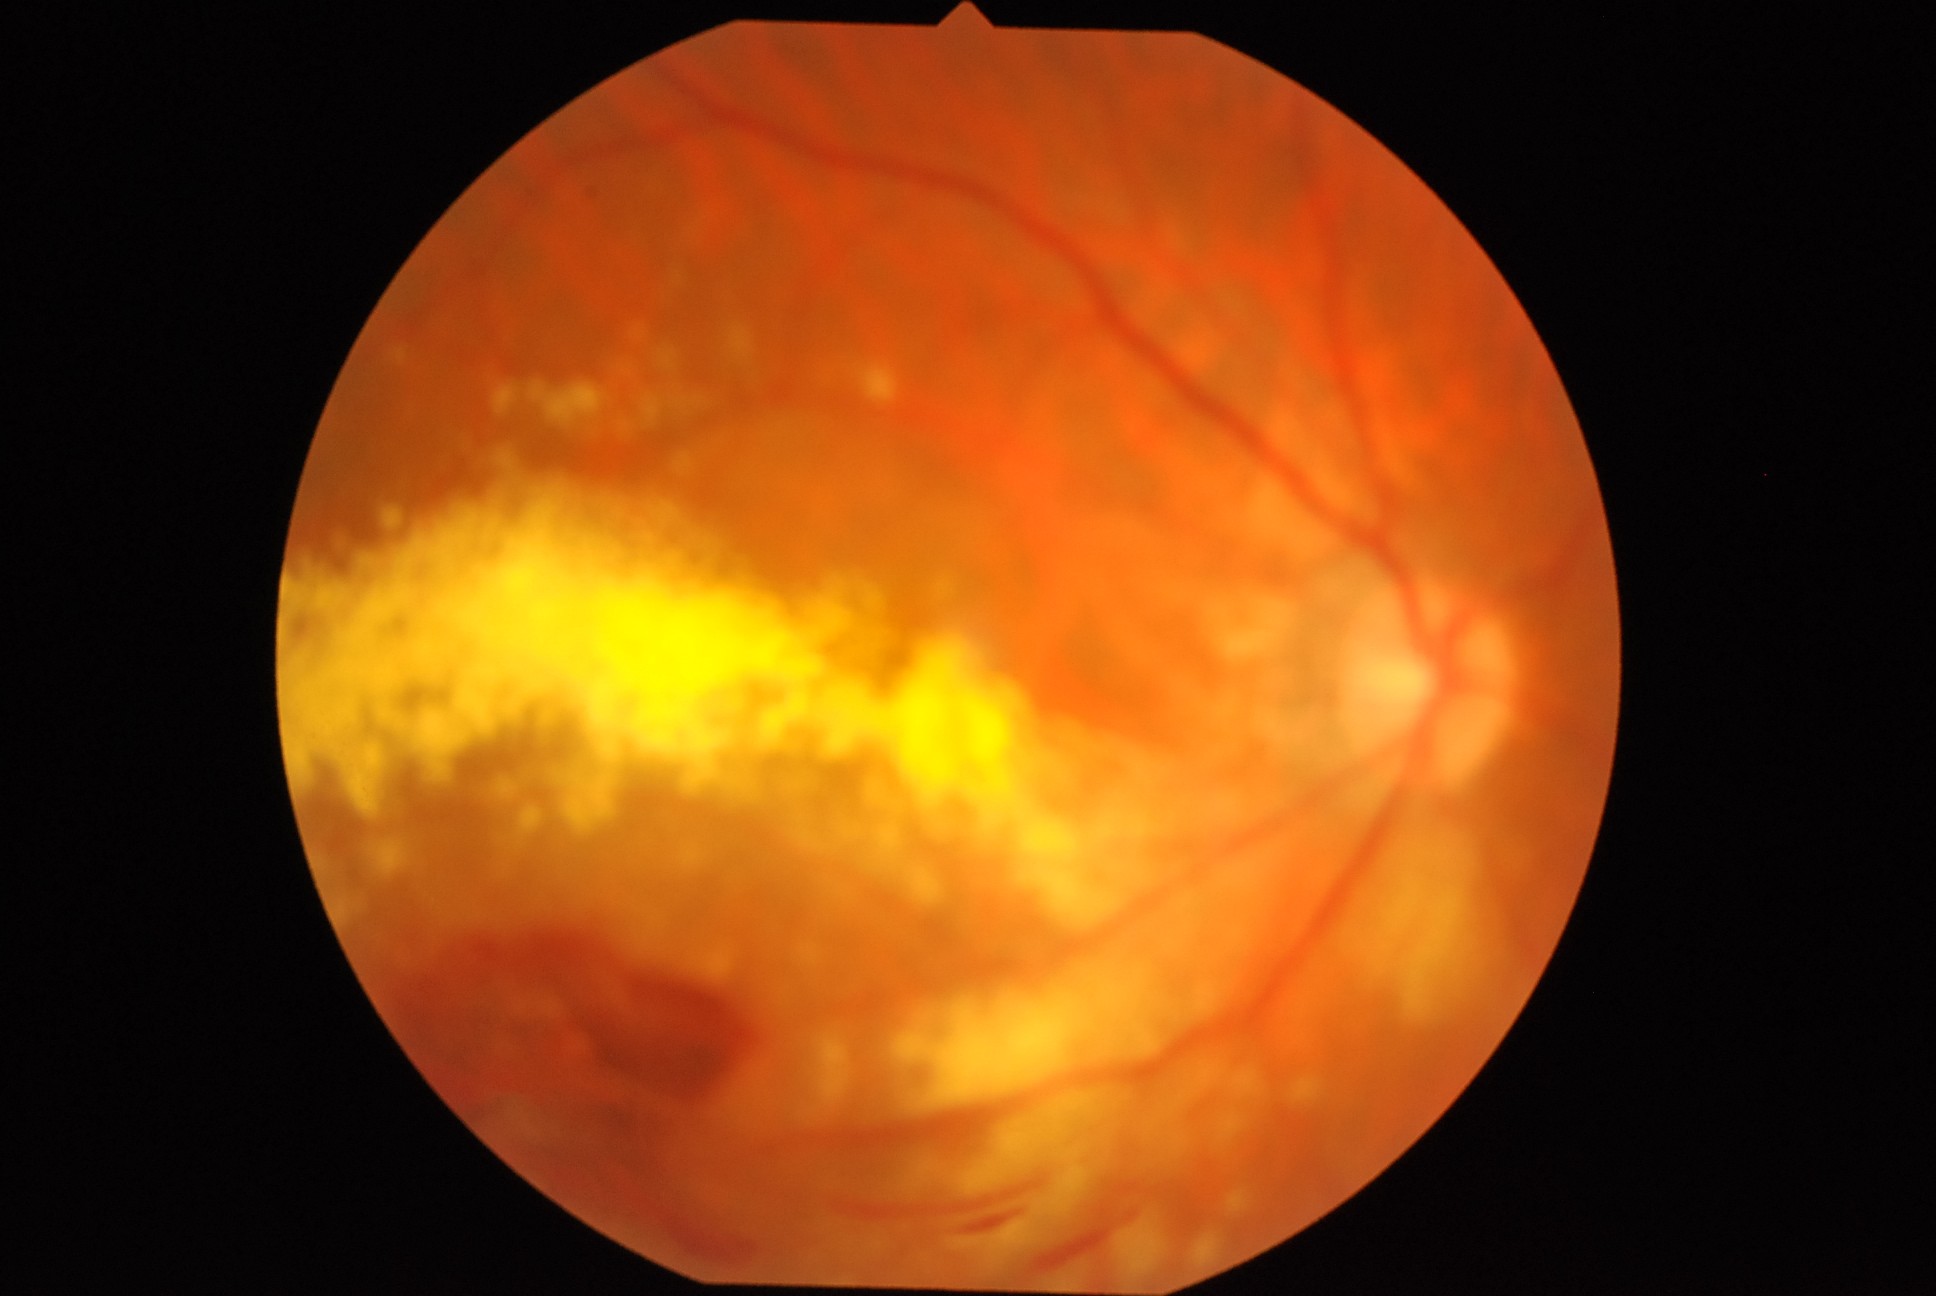 Diabetic retinopathy (DR) is grade 4 (PDR). Disease class: proliferative diabetic retinopathy.